50° FOV; posterior pole field covering the optic disc and macula; image size 2228x1652; captured after pupil dilation
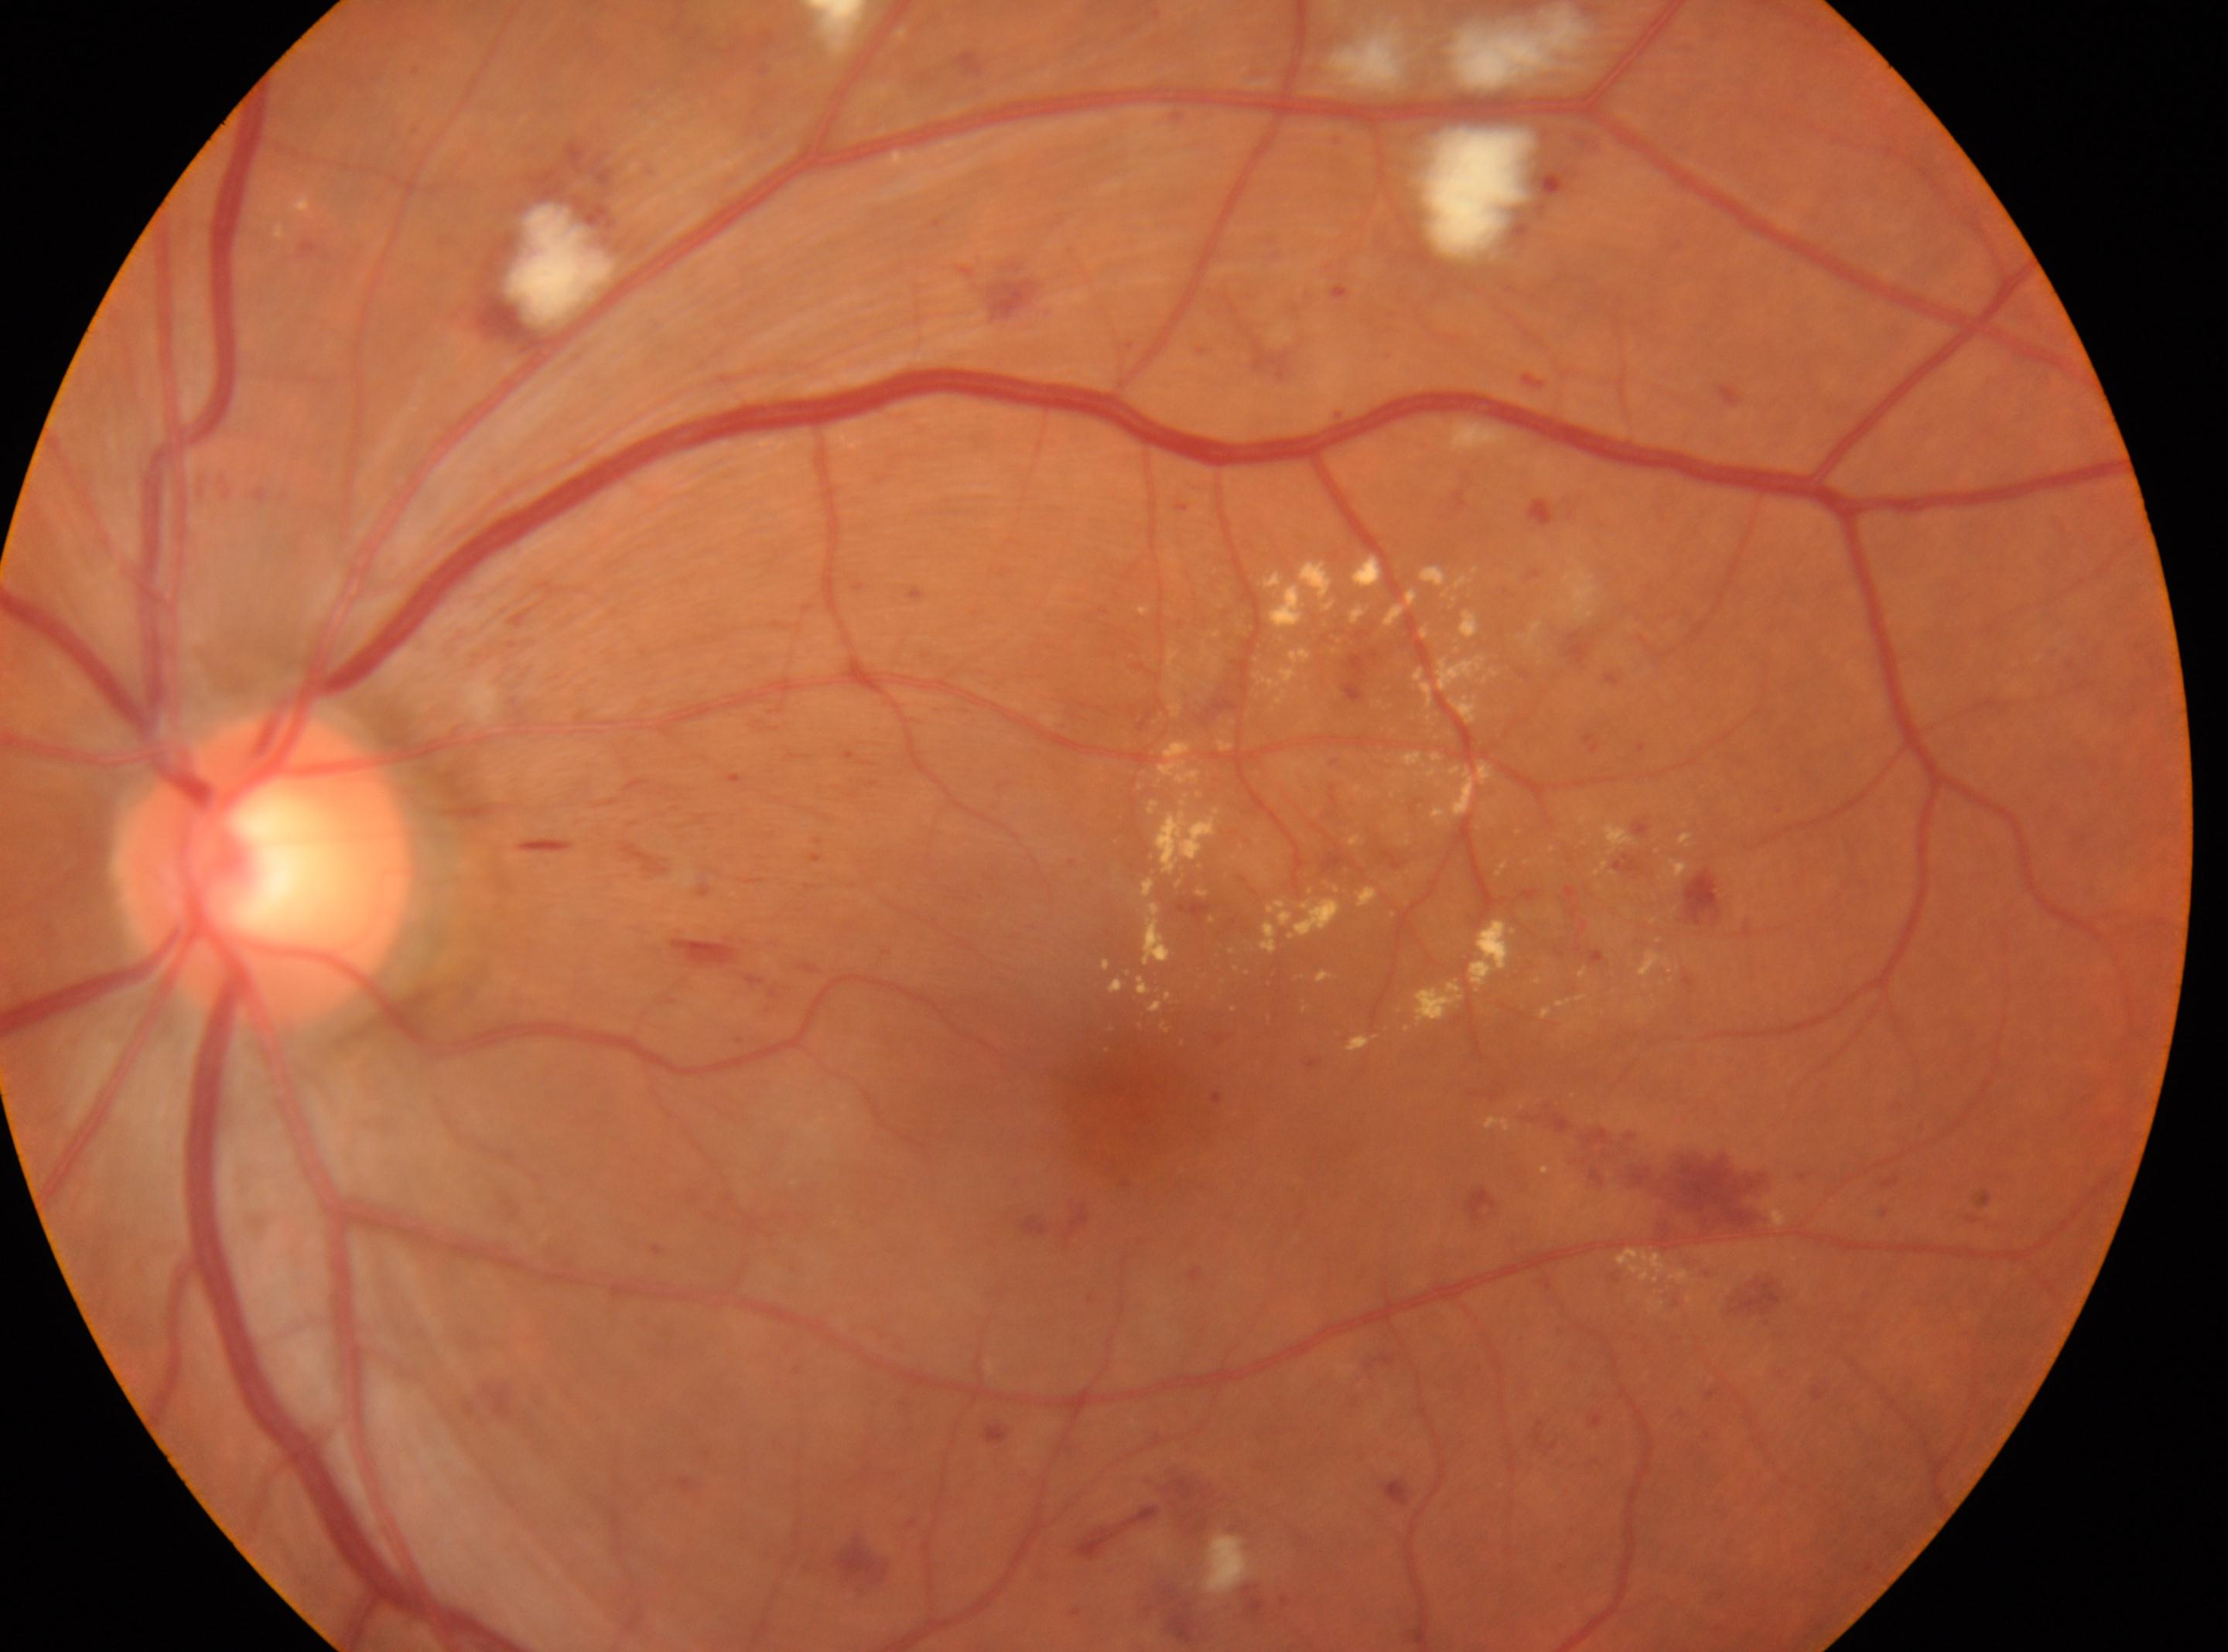
disc center: (261, 868), fovea: (1134, 1100), laterality: left eye, DR grade: 2/4 — more than just microaneurysms but less than severe NPDR.